Diabetic retinopathy graded by the modified Davis classification
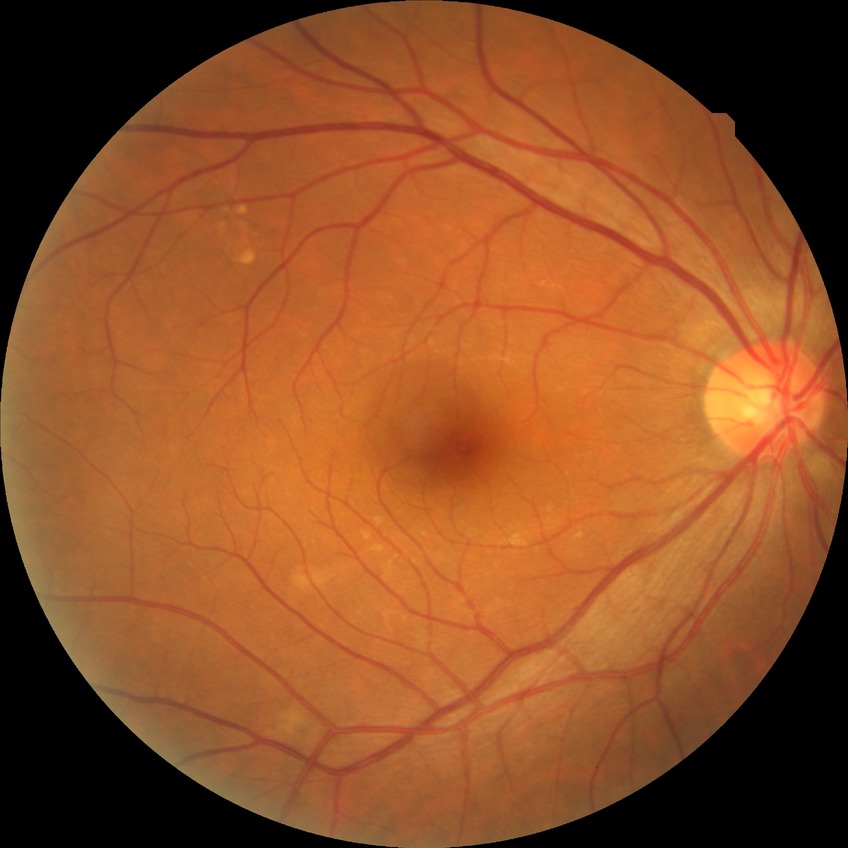
davis_grade: NDR (no diabetic retinopathy)